Posterior pole color fundus photograph; 45° field of view; nonmydriatic; NIDEK AFC-230 — 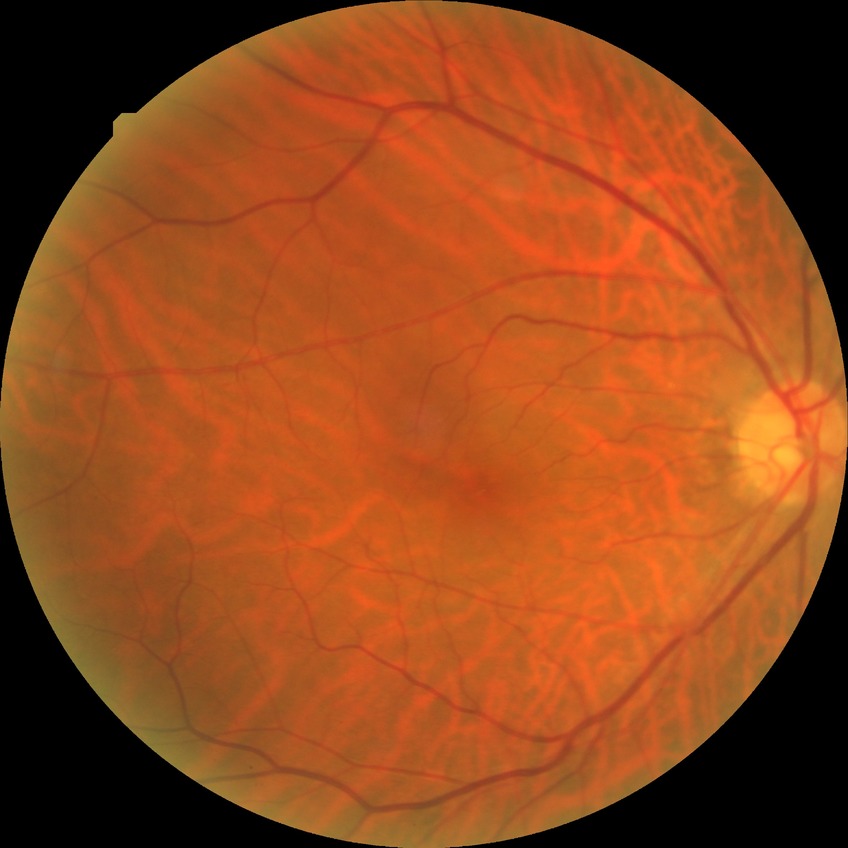
– Davis DR grade — NDR